FOV: 45 degrees:
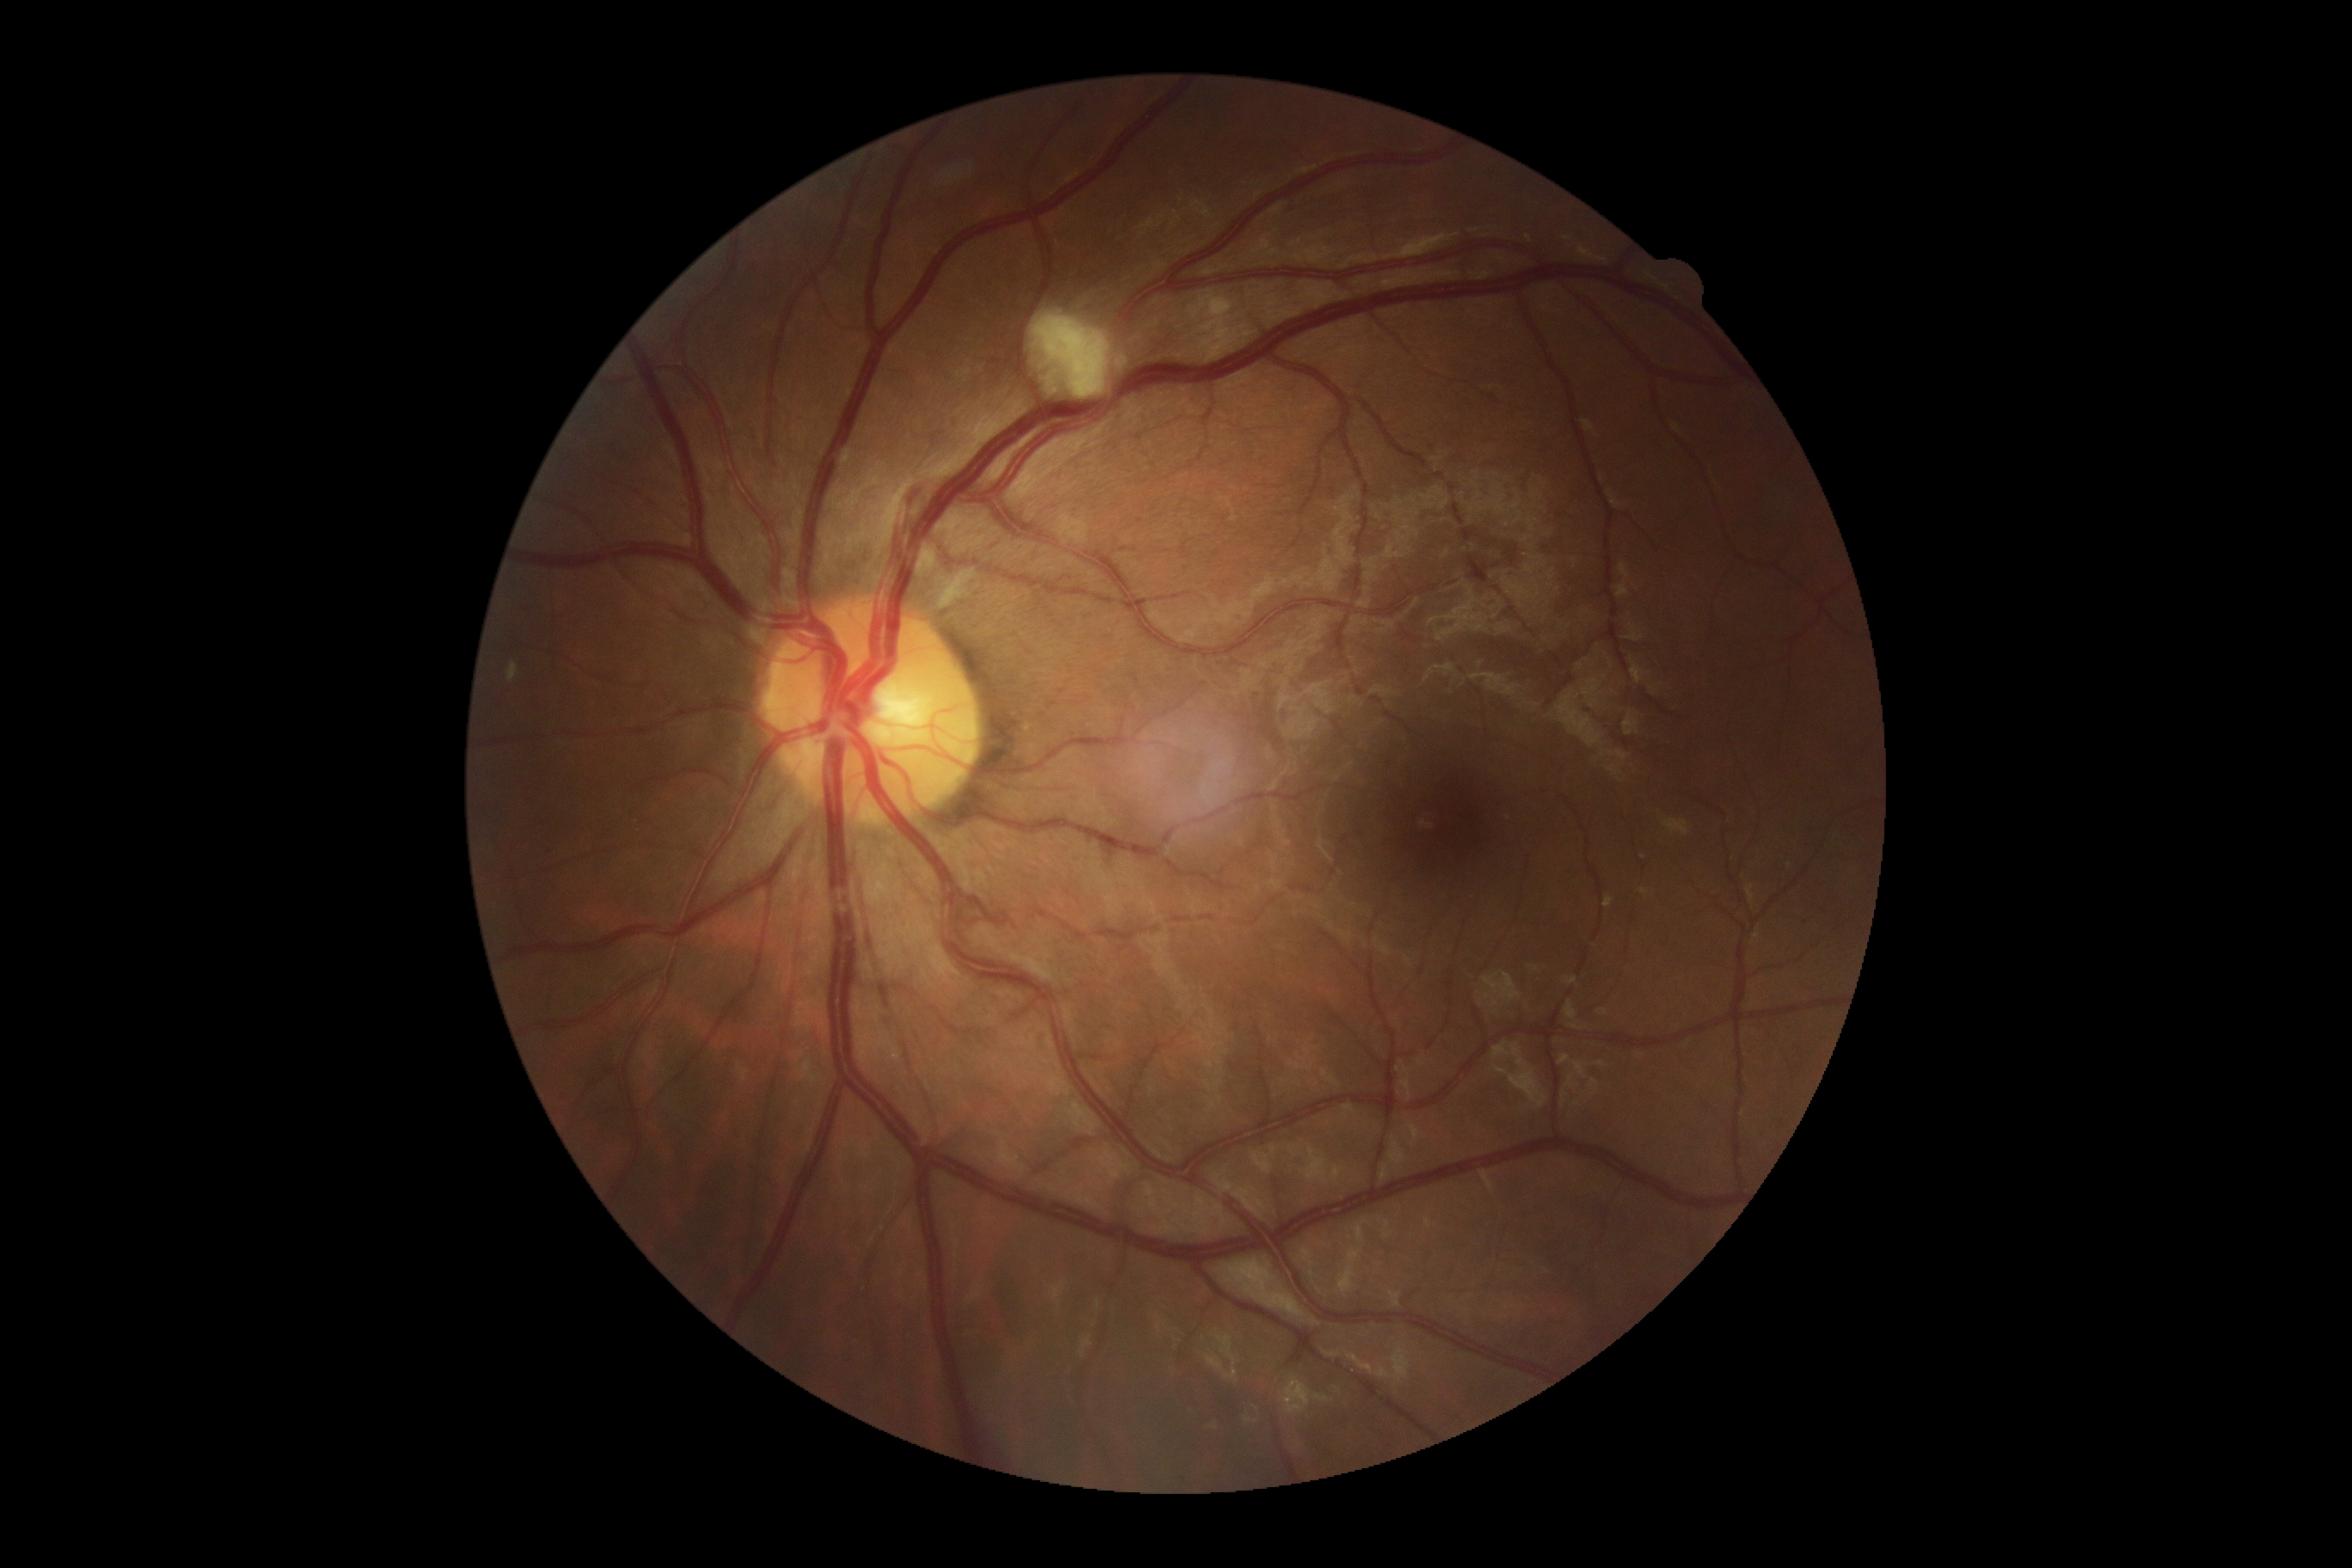

  dr_grade: 2/4
  dr_category: non-proliferative diabetic retinopathy